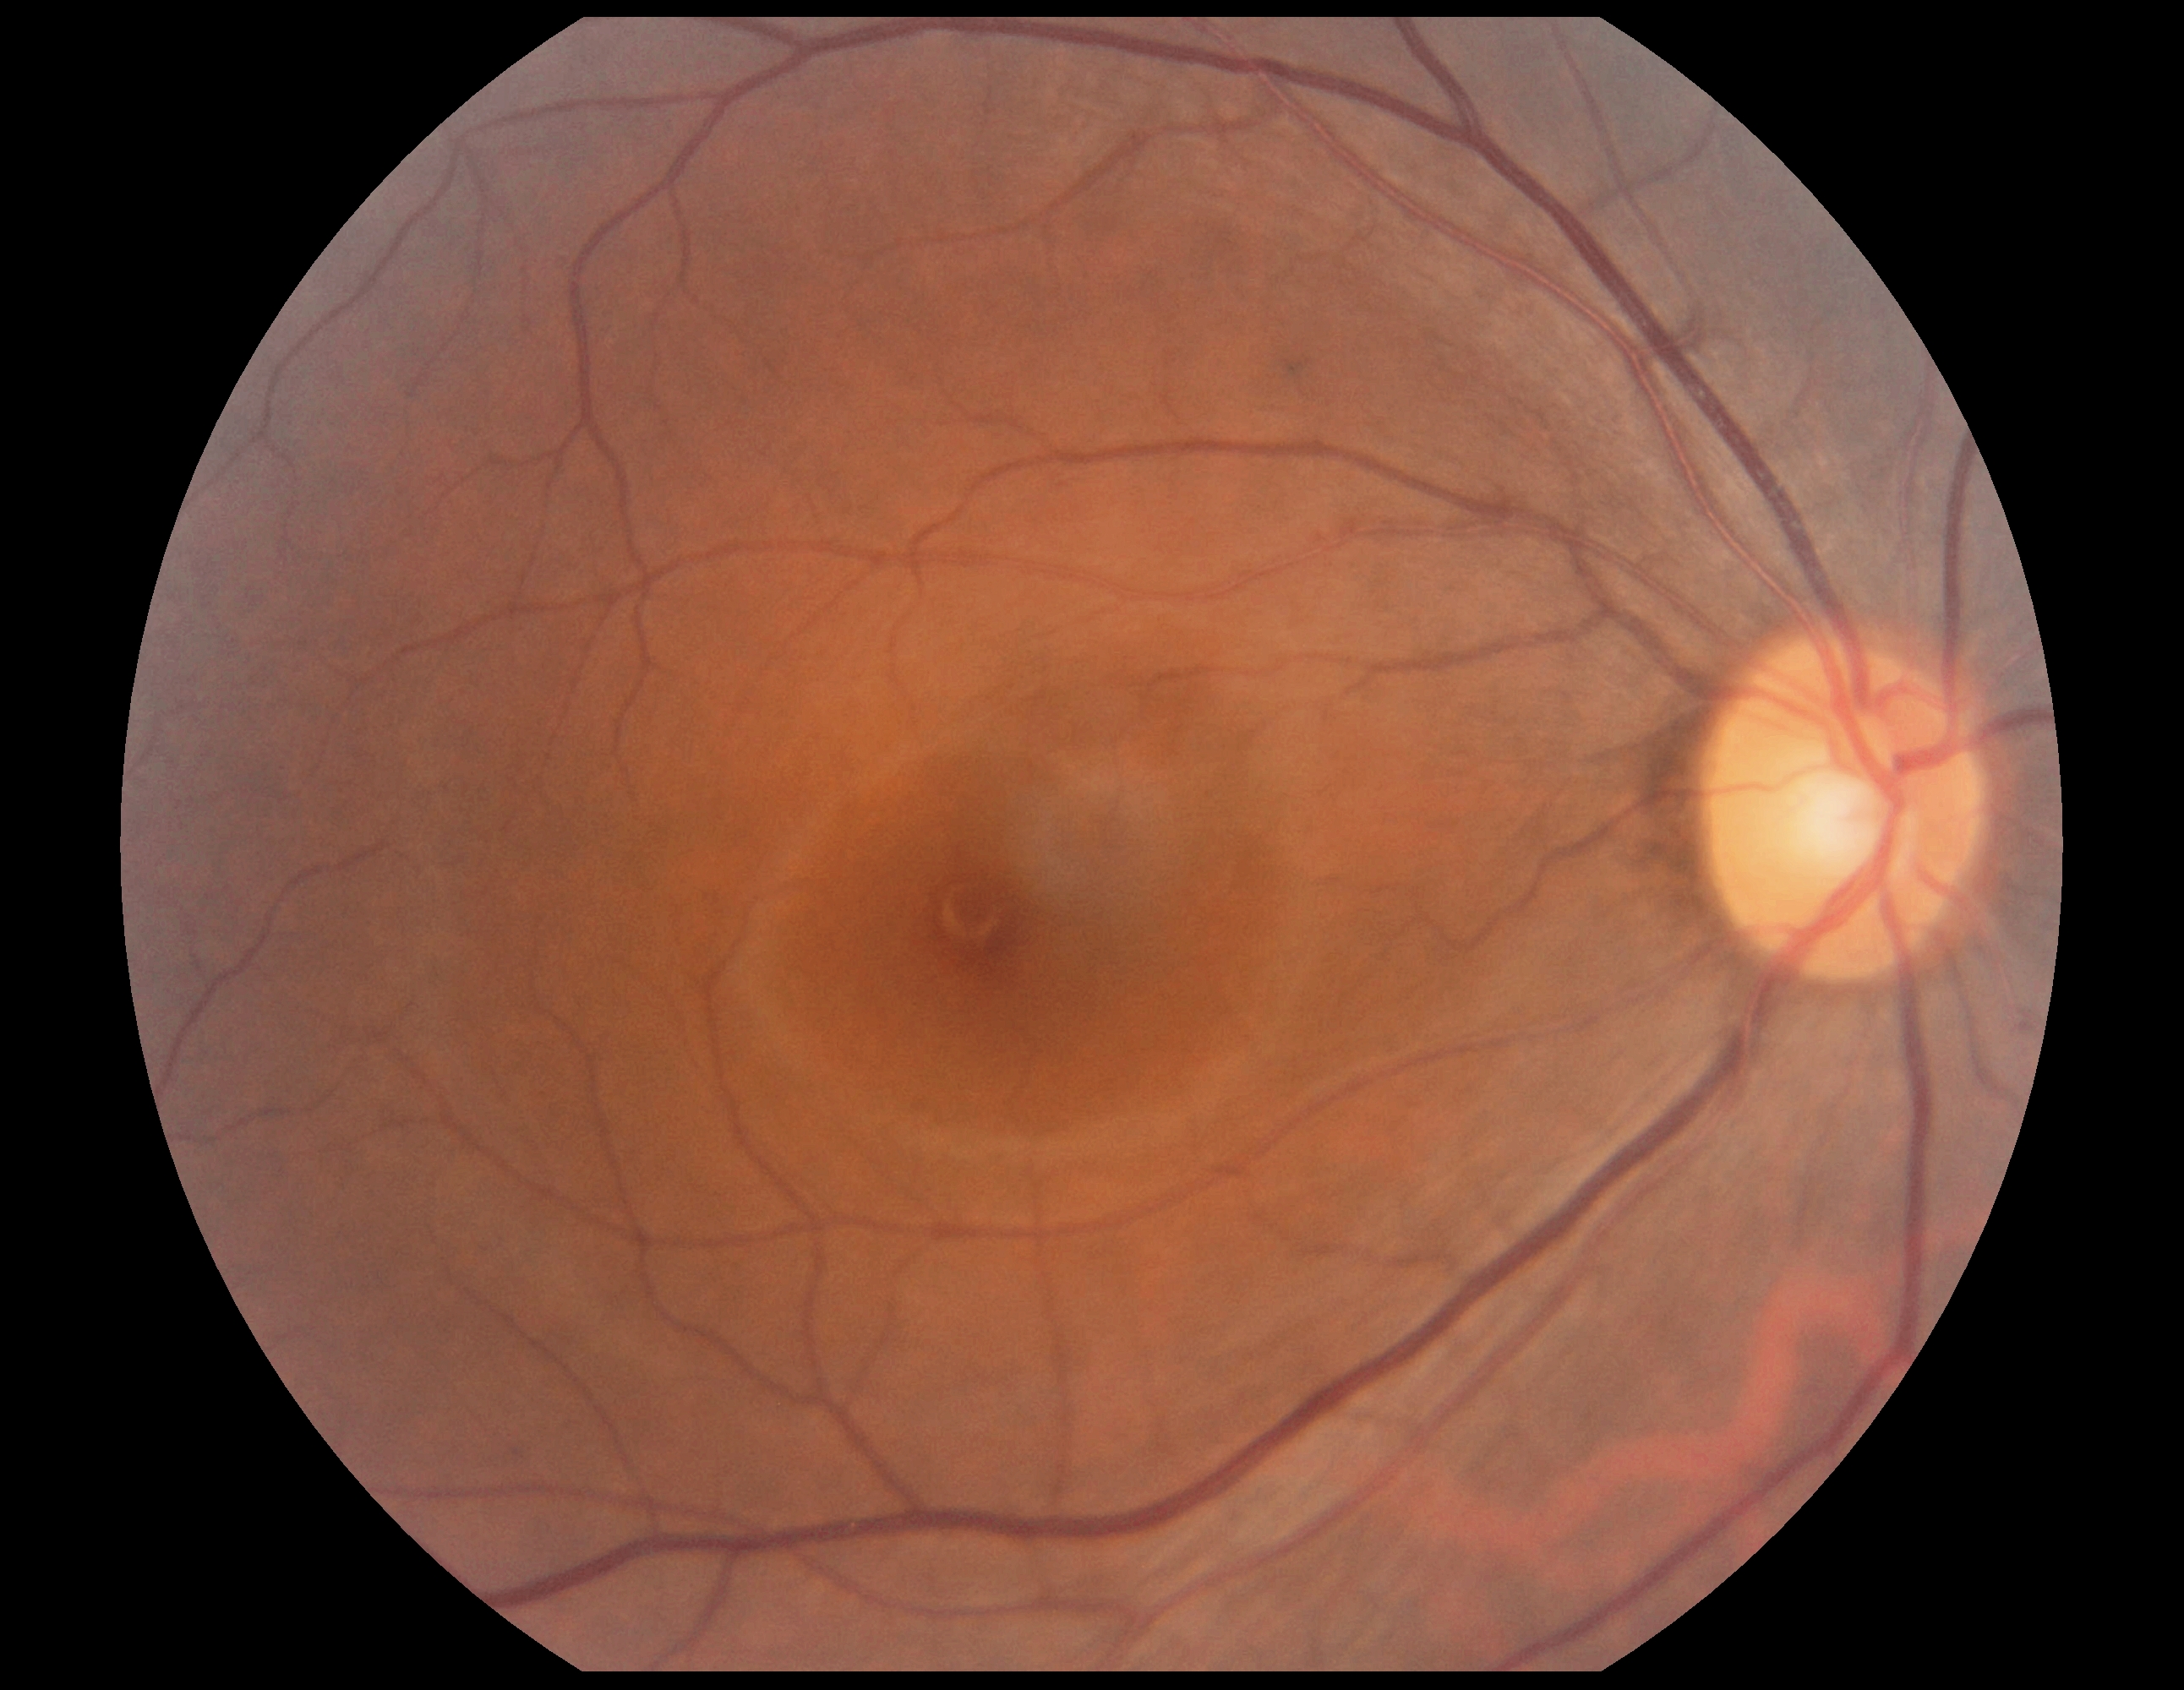

Diabetic retinopathy (DR): grade 0 (no apparent retinopathy).